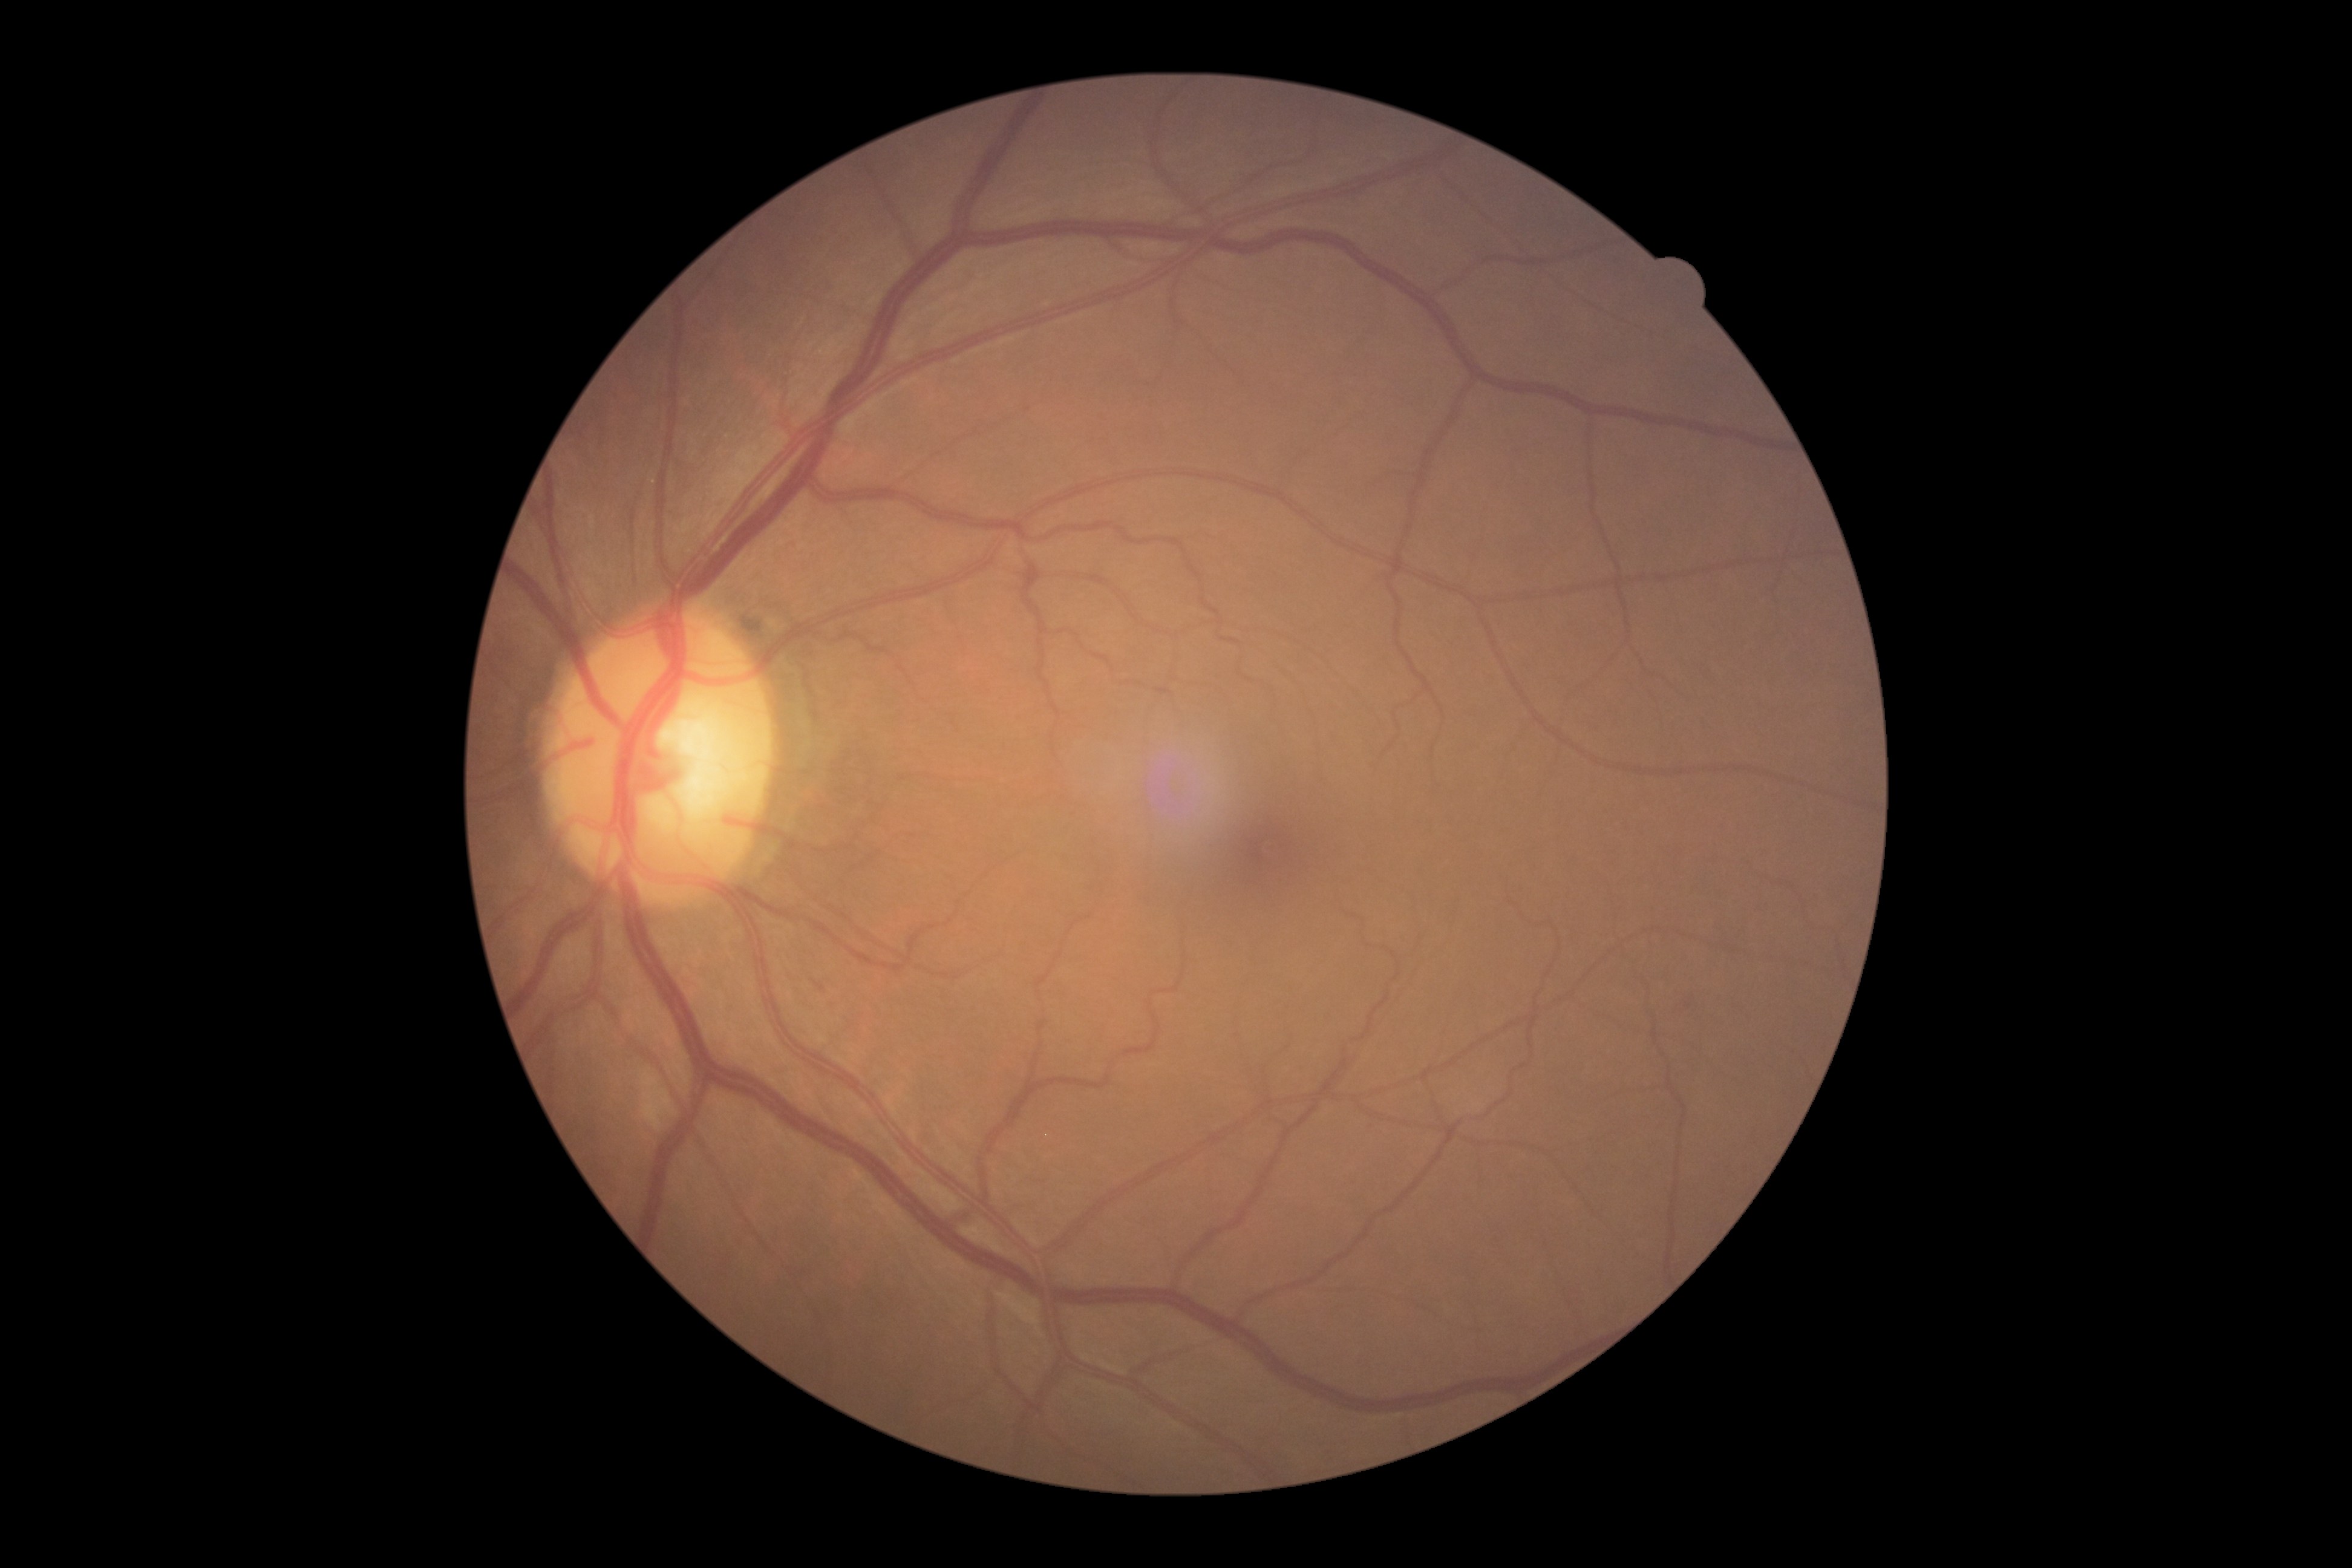
diabetic retinopathy (DR): grade 0 (no apparent retinopathy); DR impression: no apparent DR.